45° field of view. CFP. 2352 x 1568 pixels.
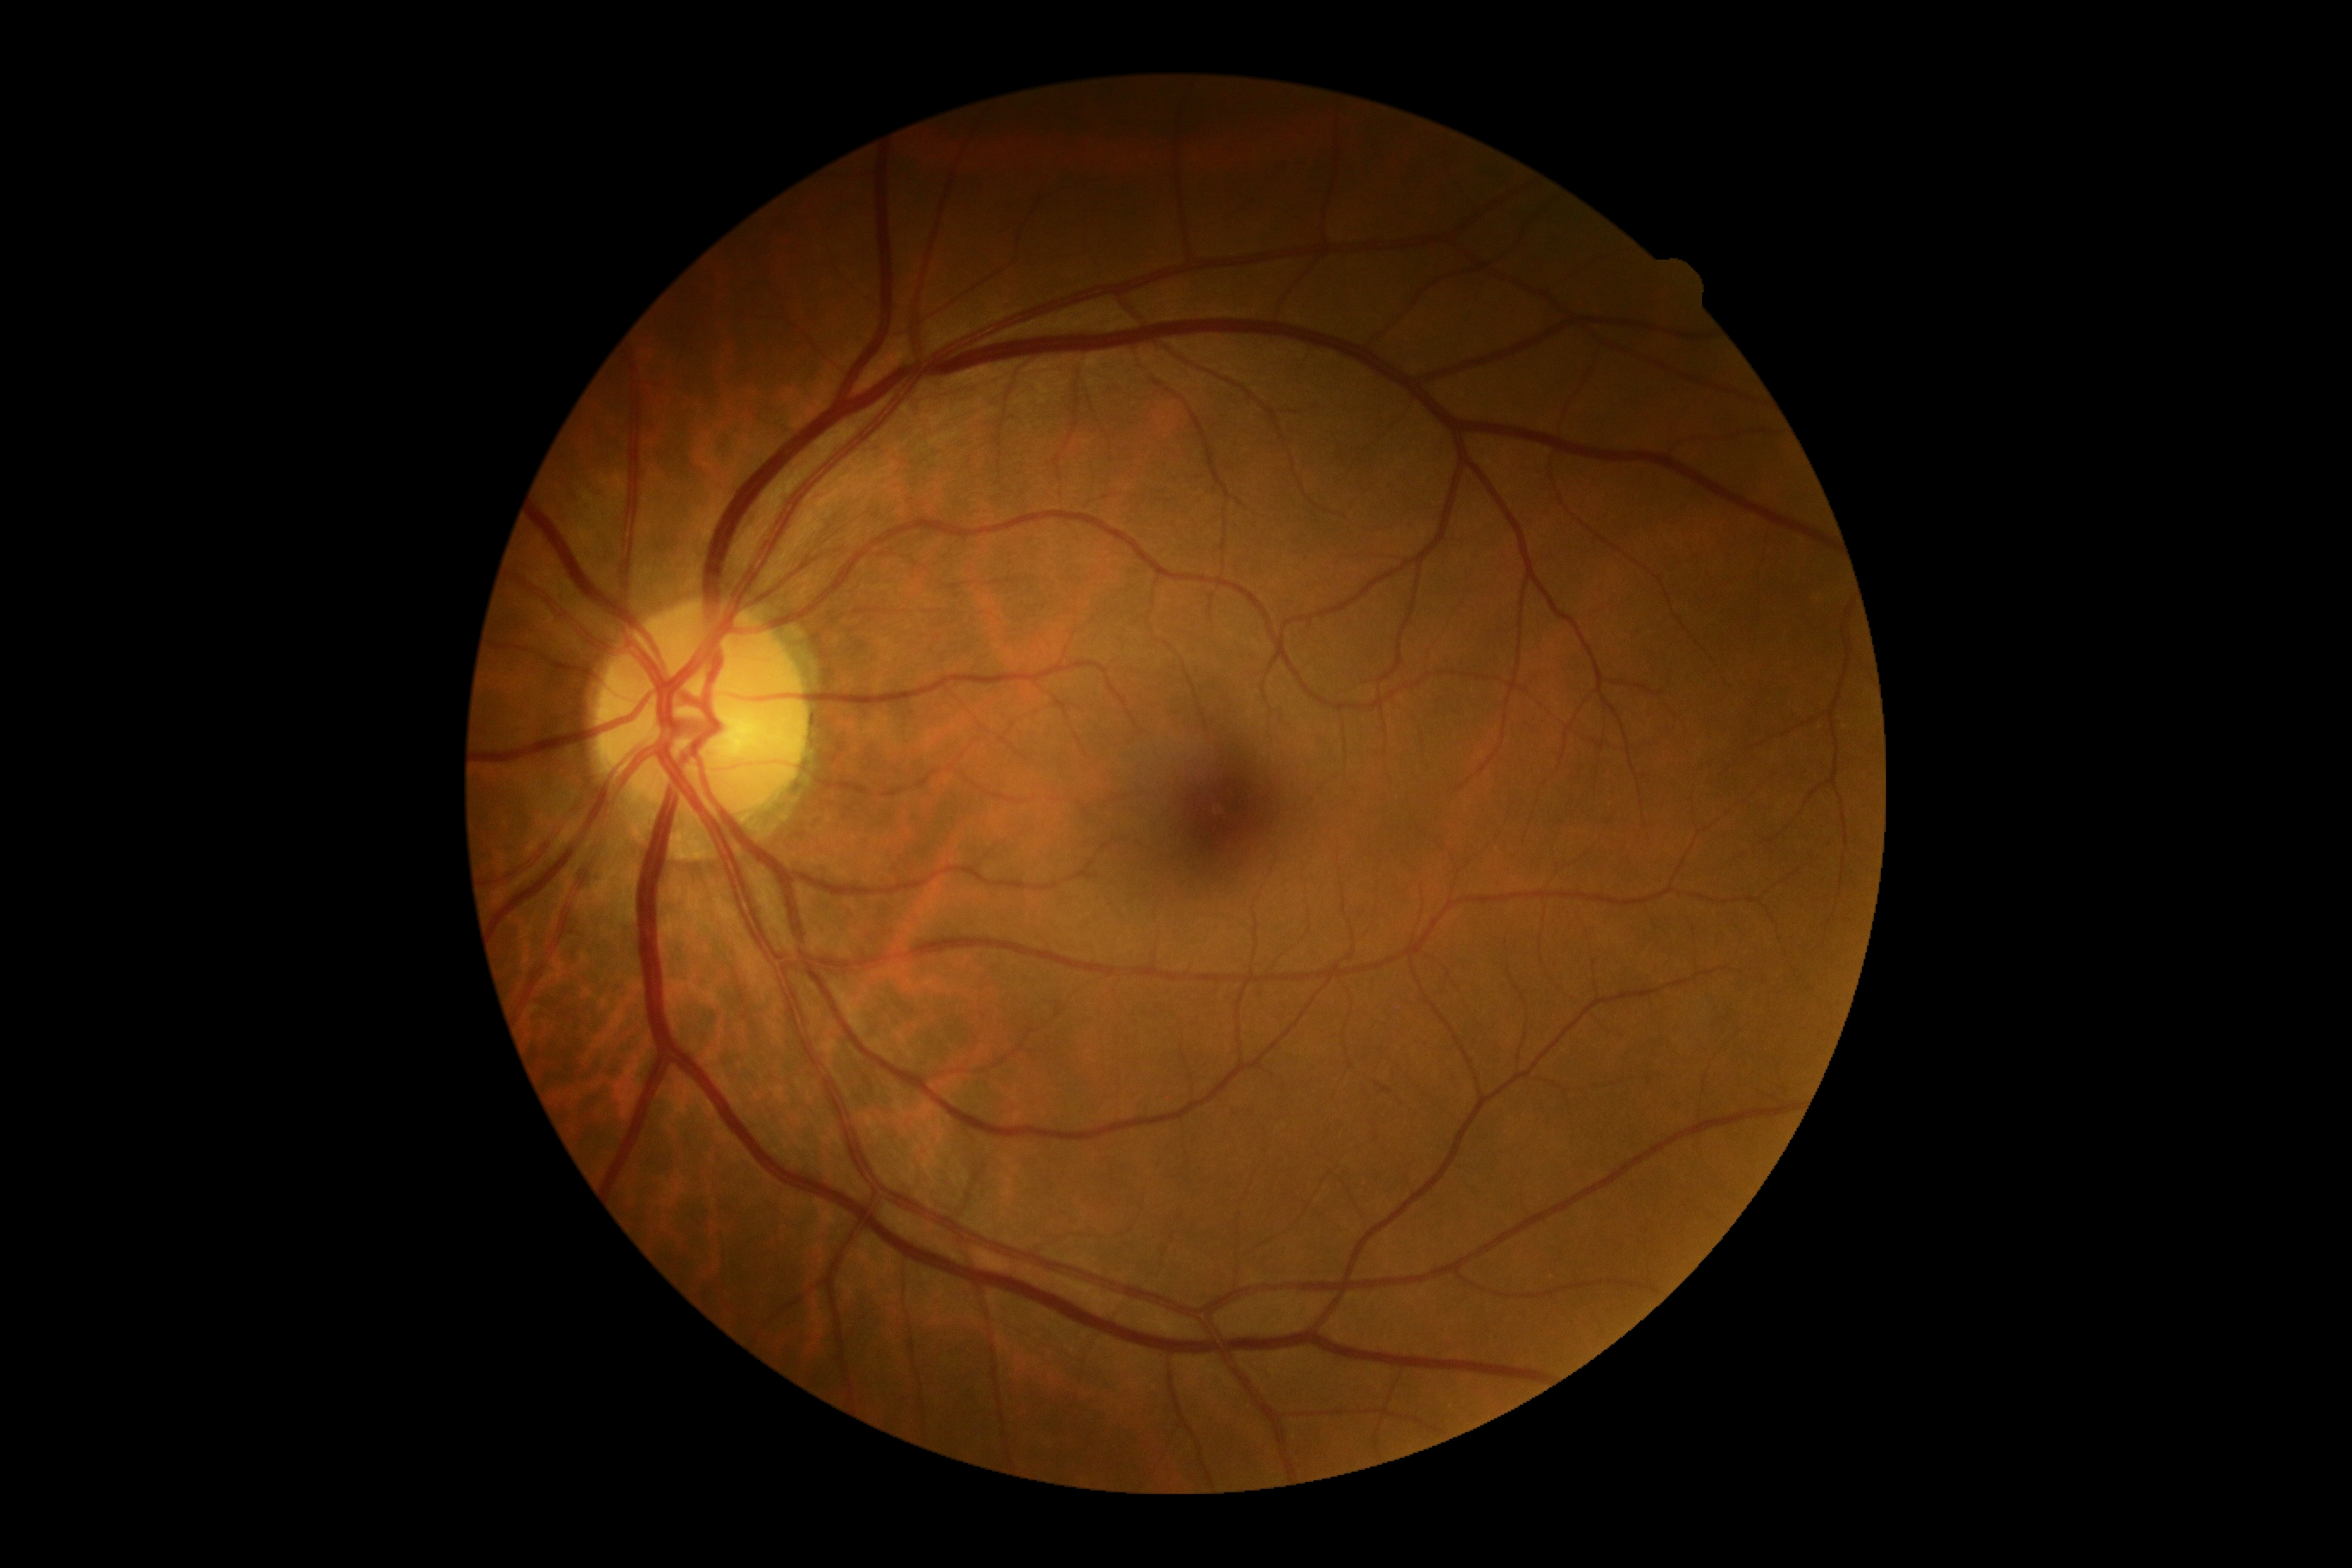
Retinopathy grade is 0/4 — no visible signs of diabetic retinopathy.
No DR findings.